45° field of view:
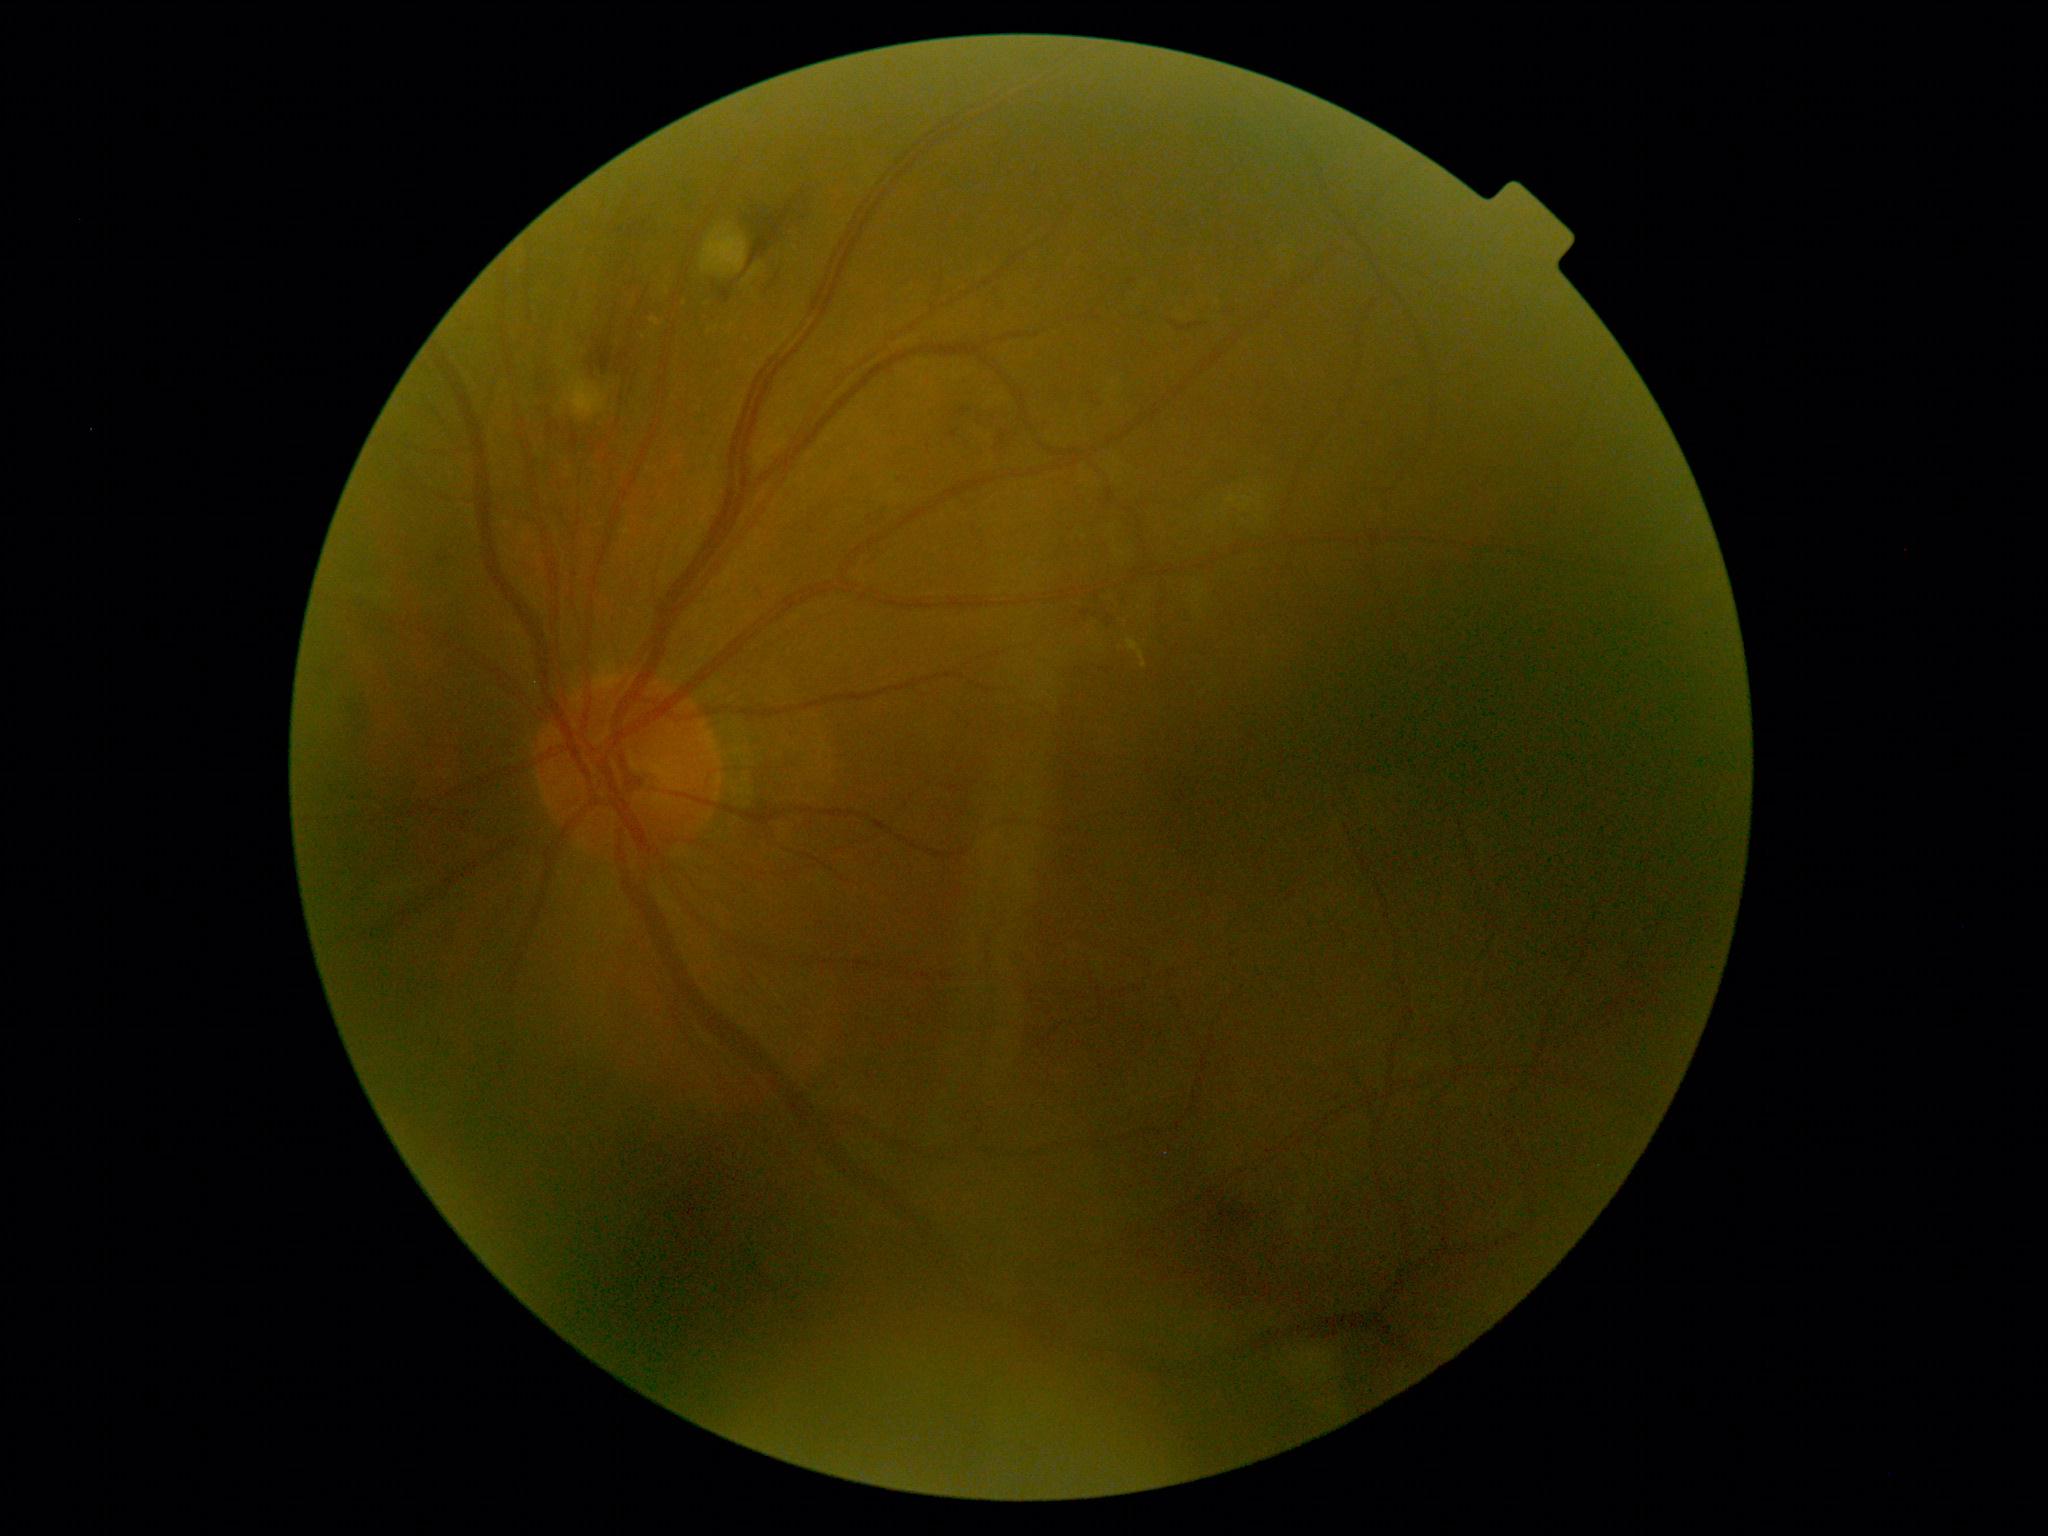 DR class: non-proliferative diabetic retinopathy, diabetic retinopathy severity: grade 2.